DR severity per modified Davis staging — 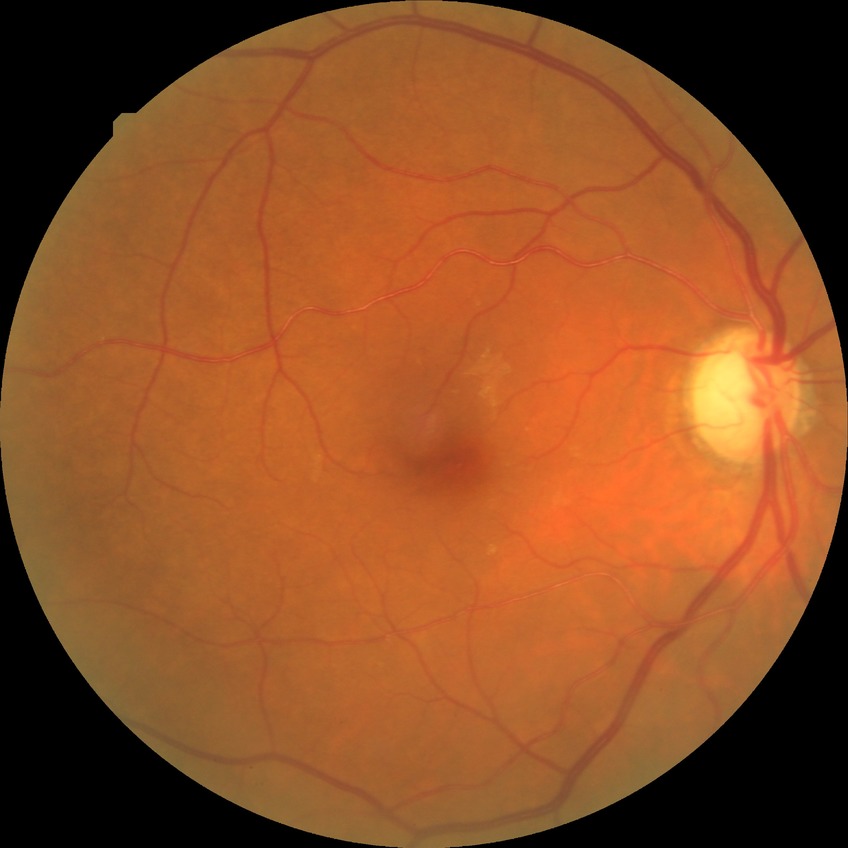 diabetic retinopathy (DR)@no diabetic retinopathy (NDR).